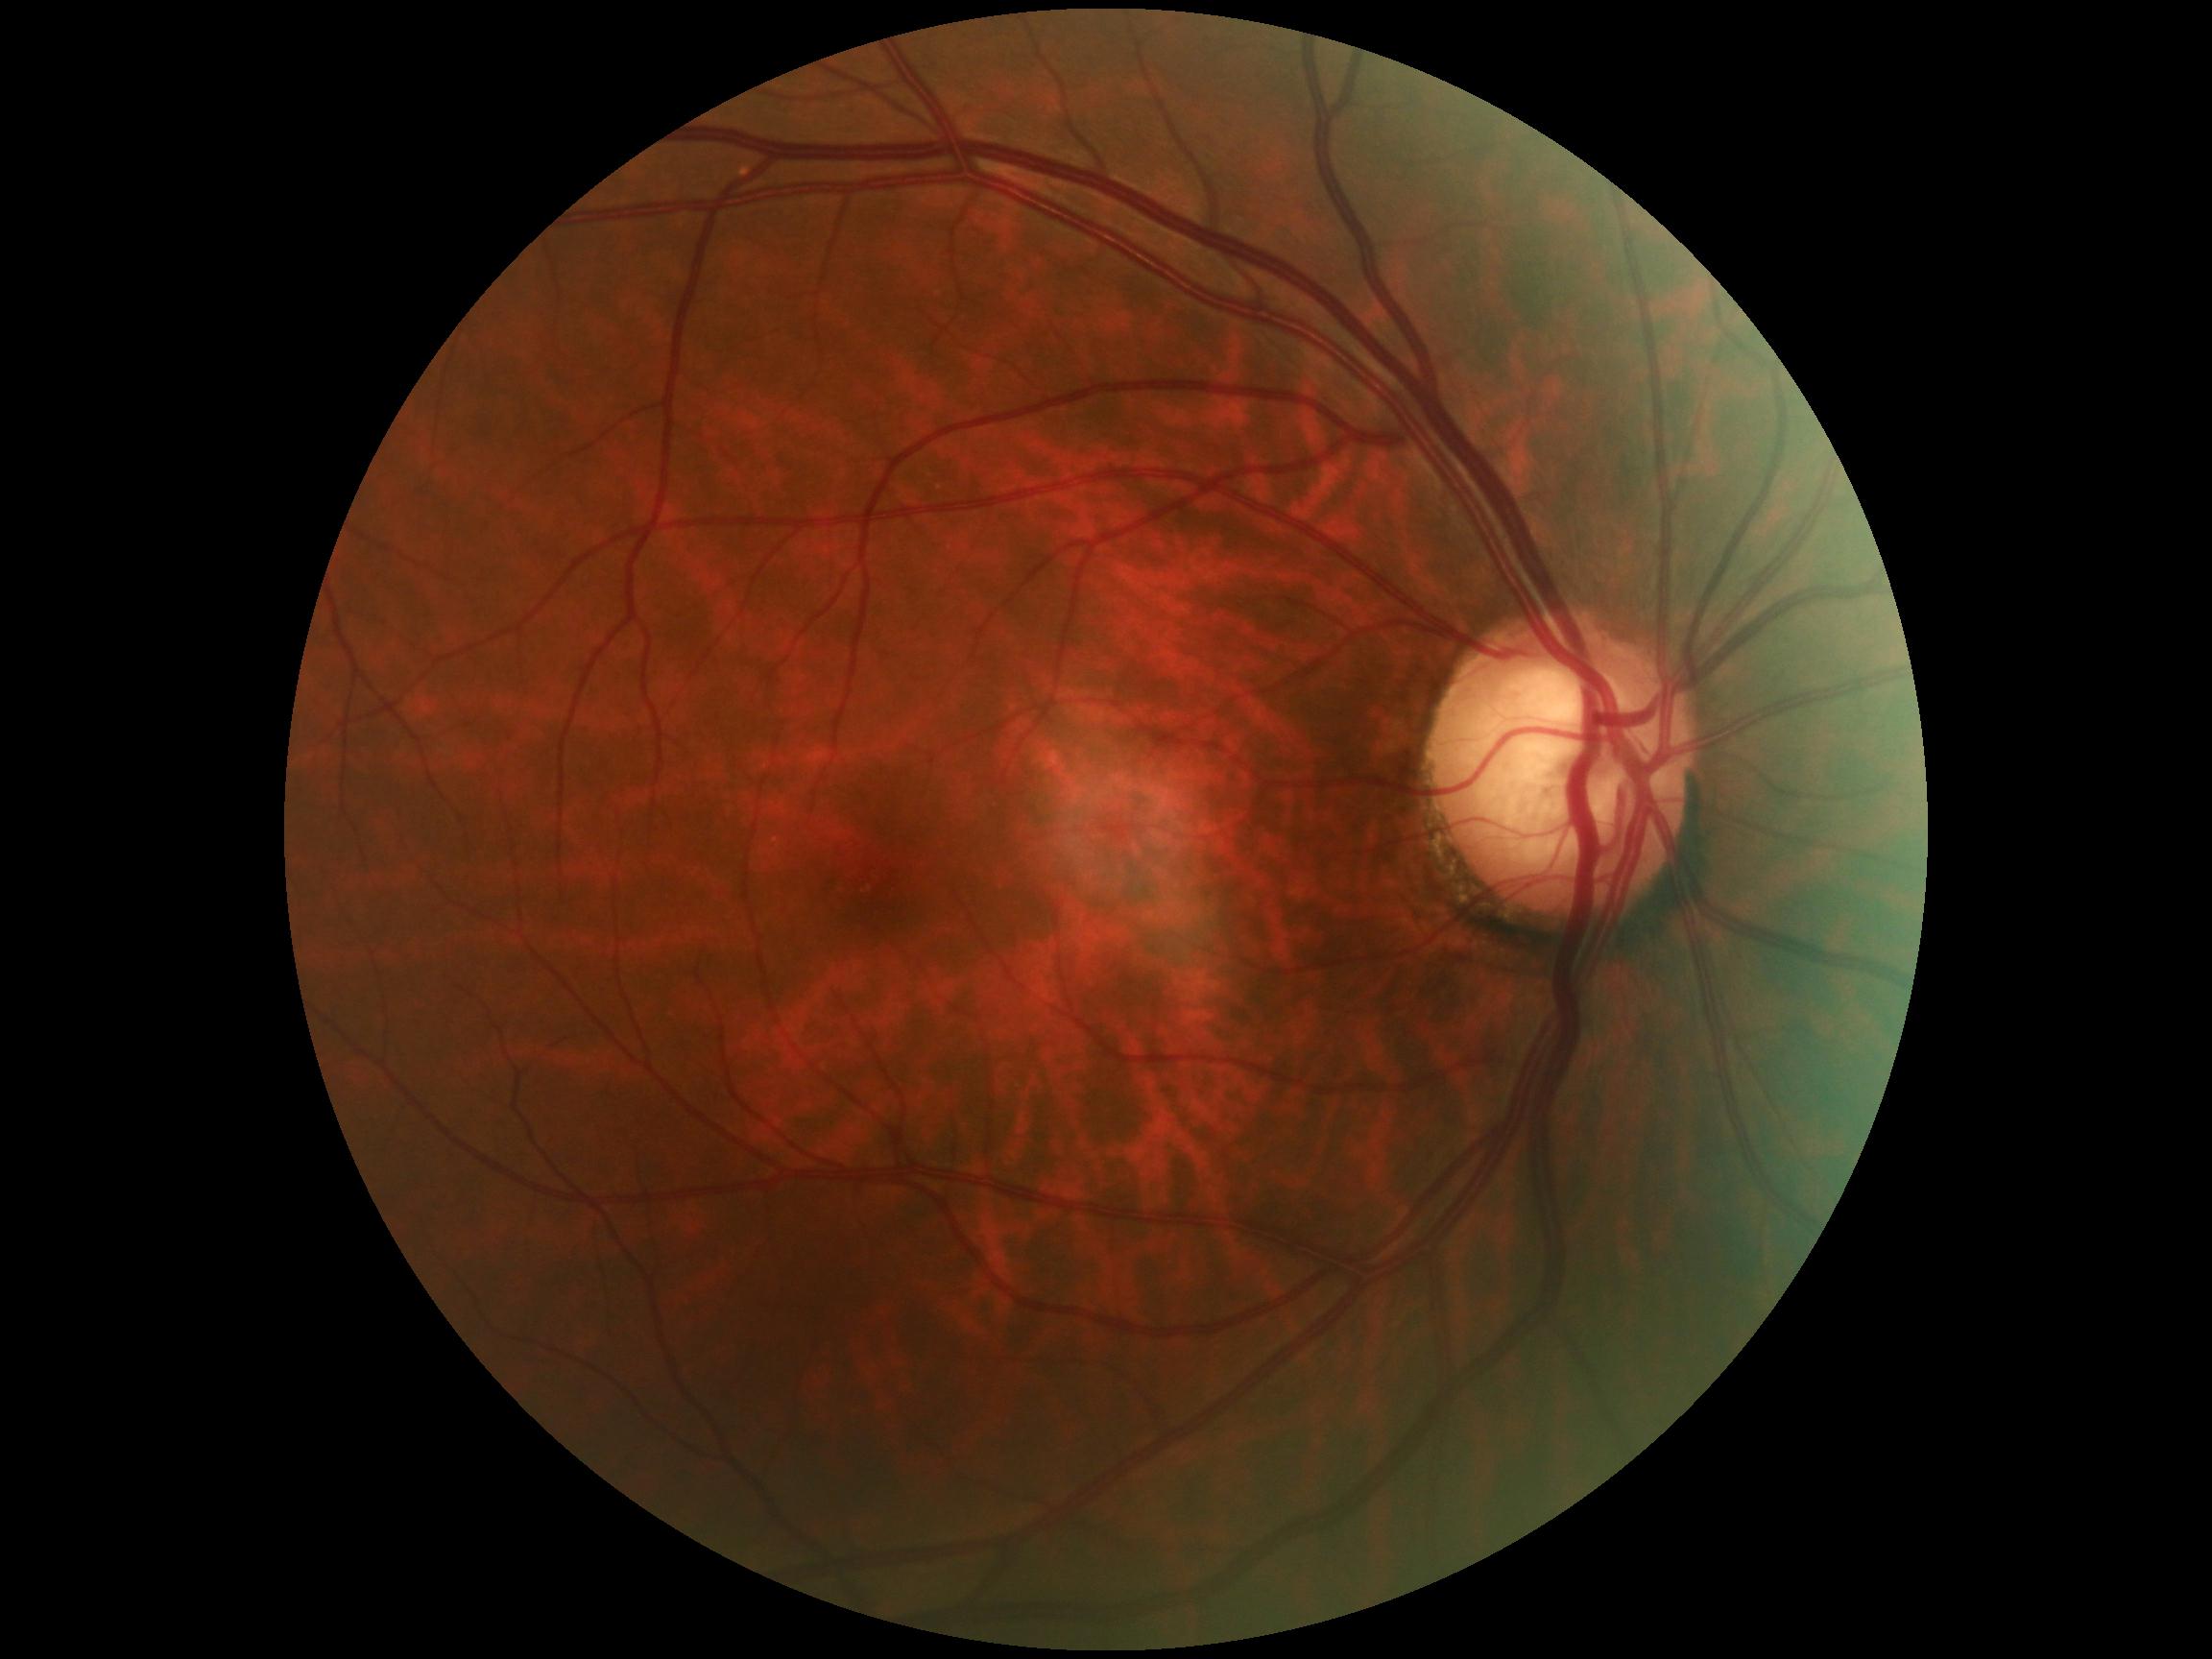
{
  "dr_grade": "grade 0"
}